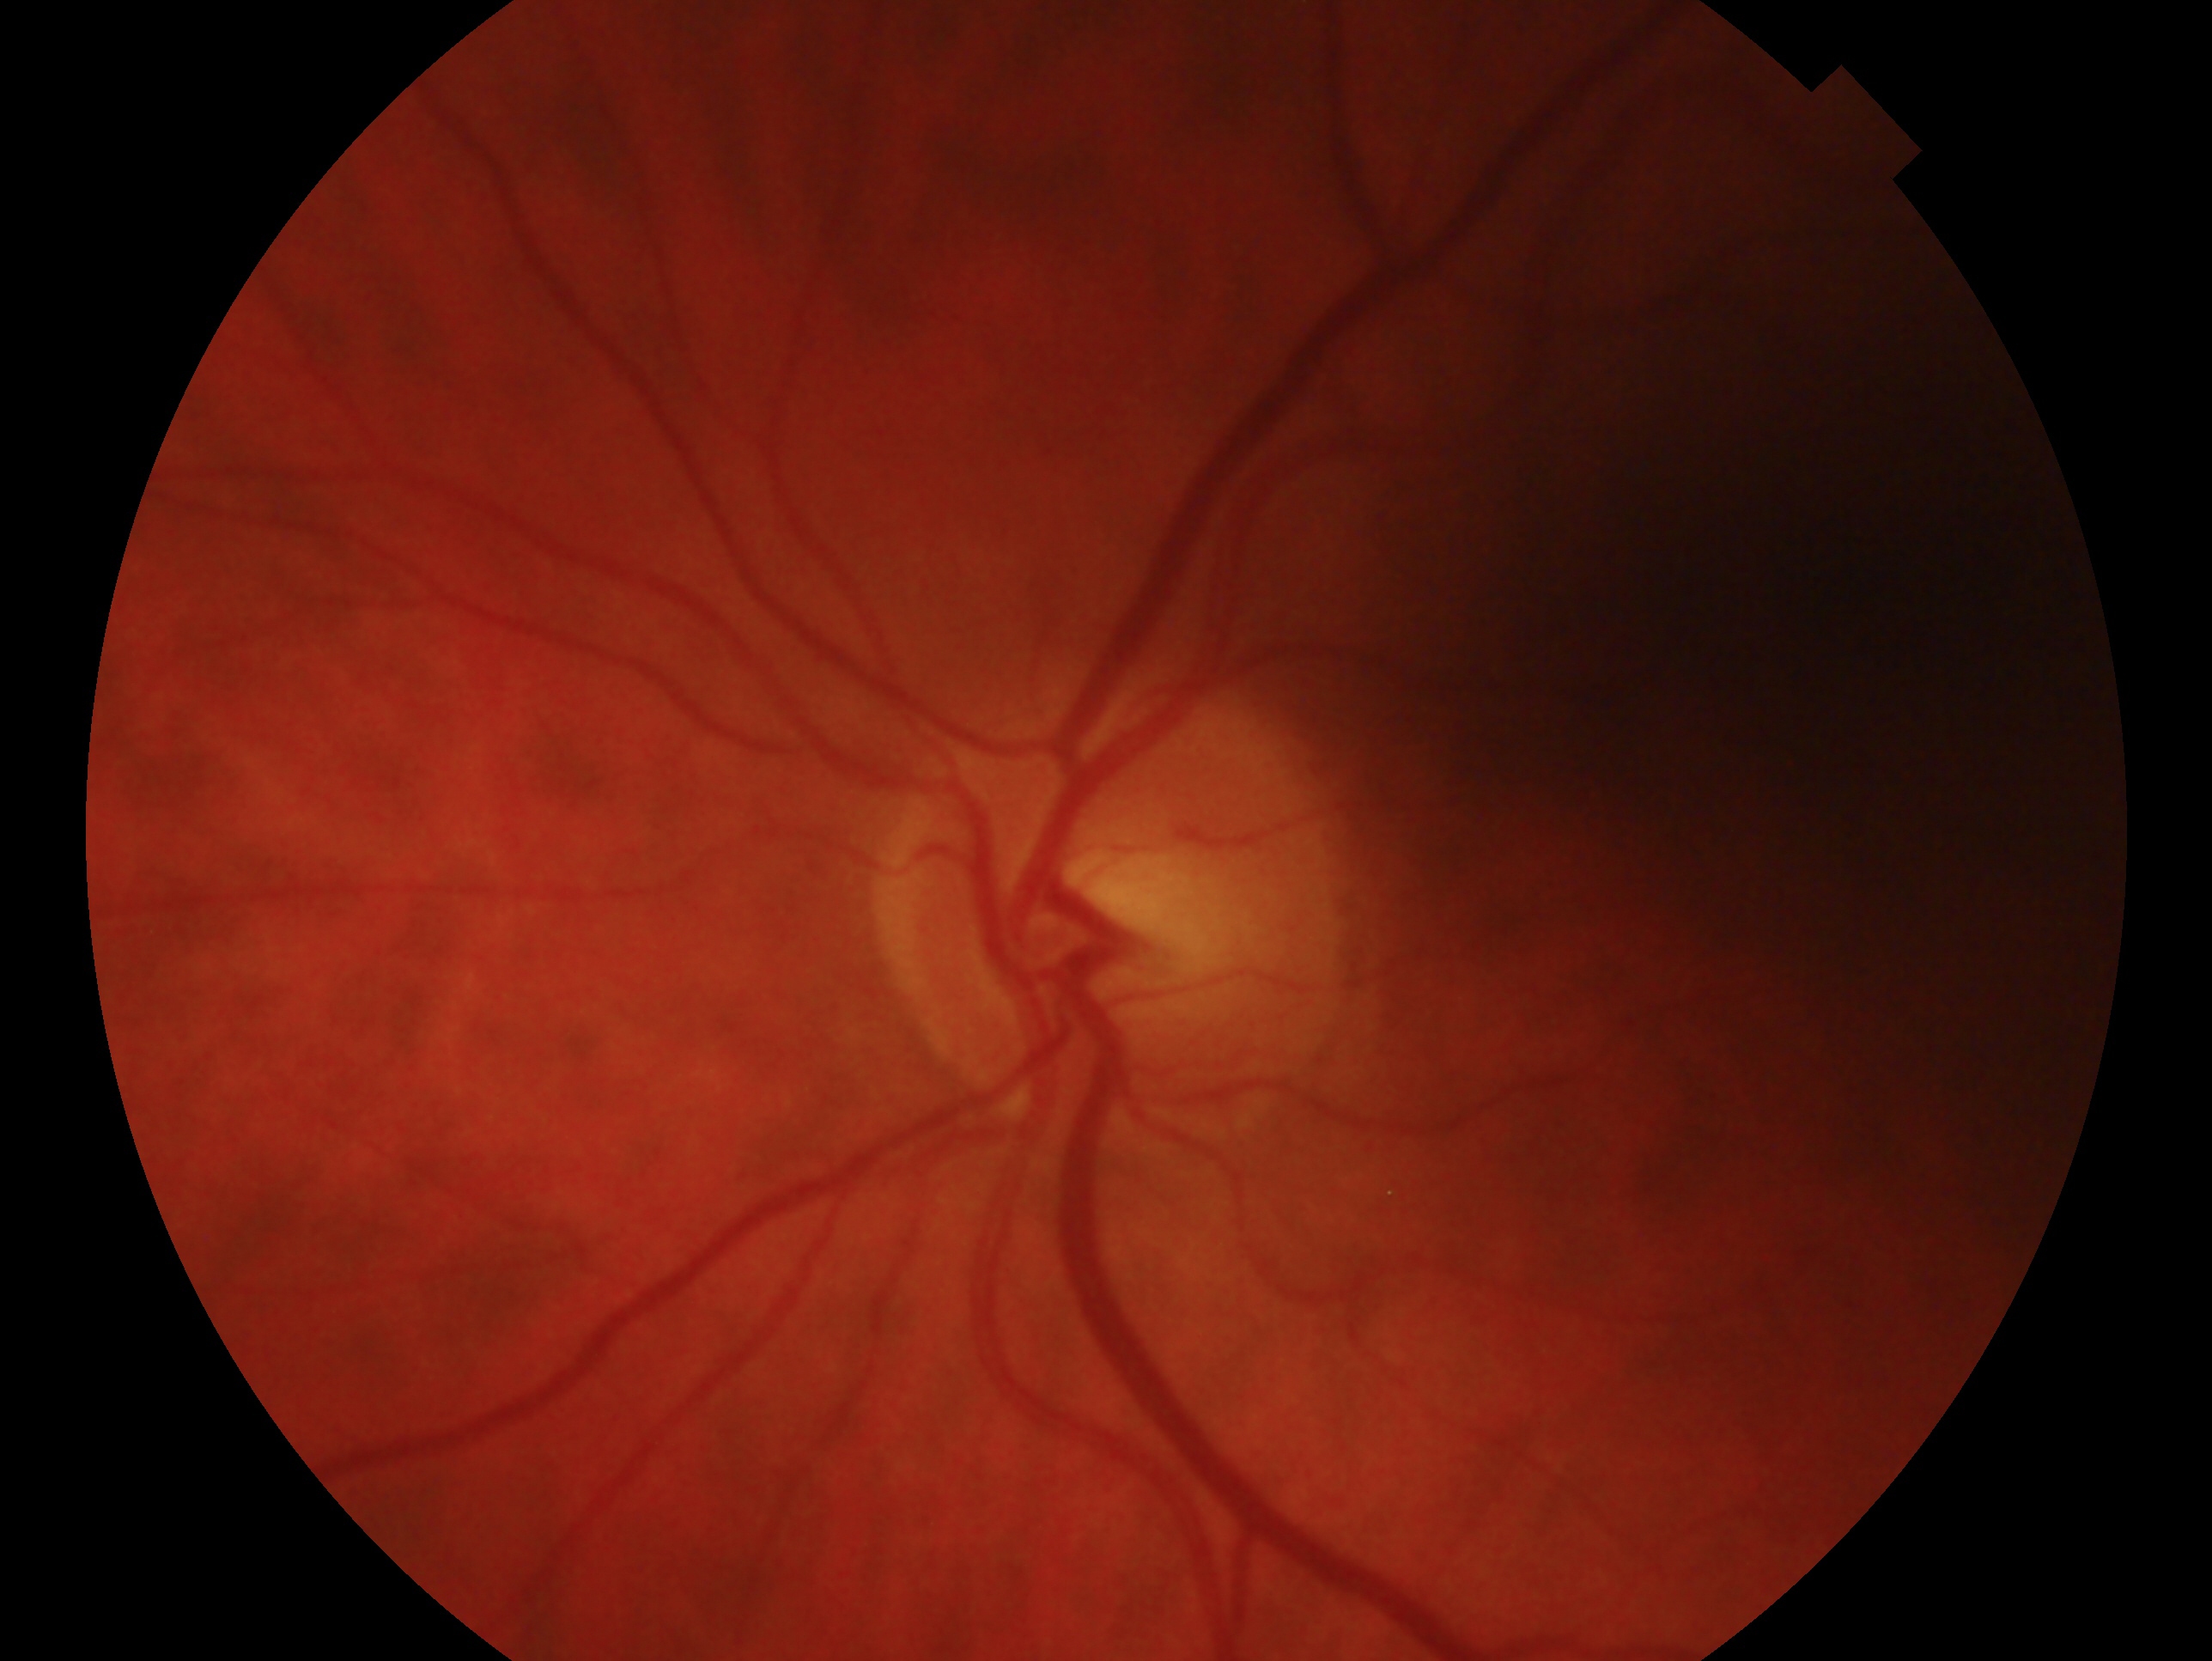 Glaucoma assessment: no signs of glaucoma. Eye: OS.